1536 x 1152 pixels: 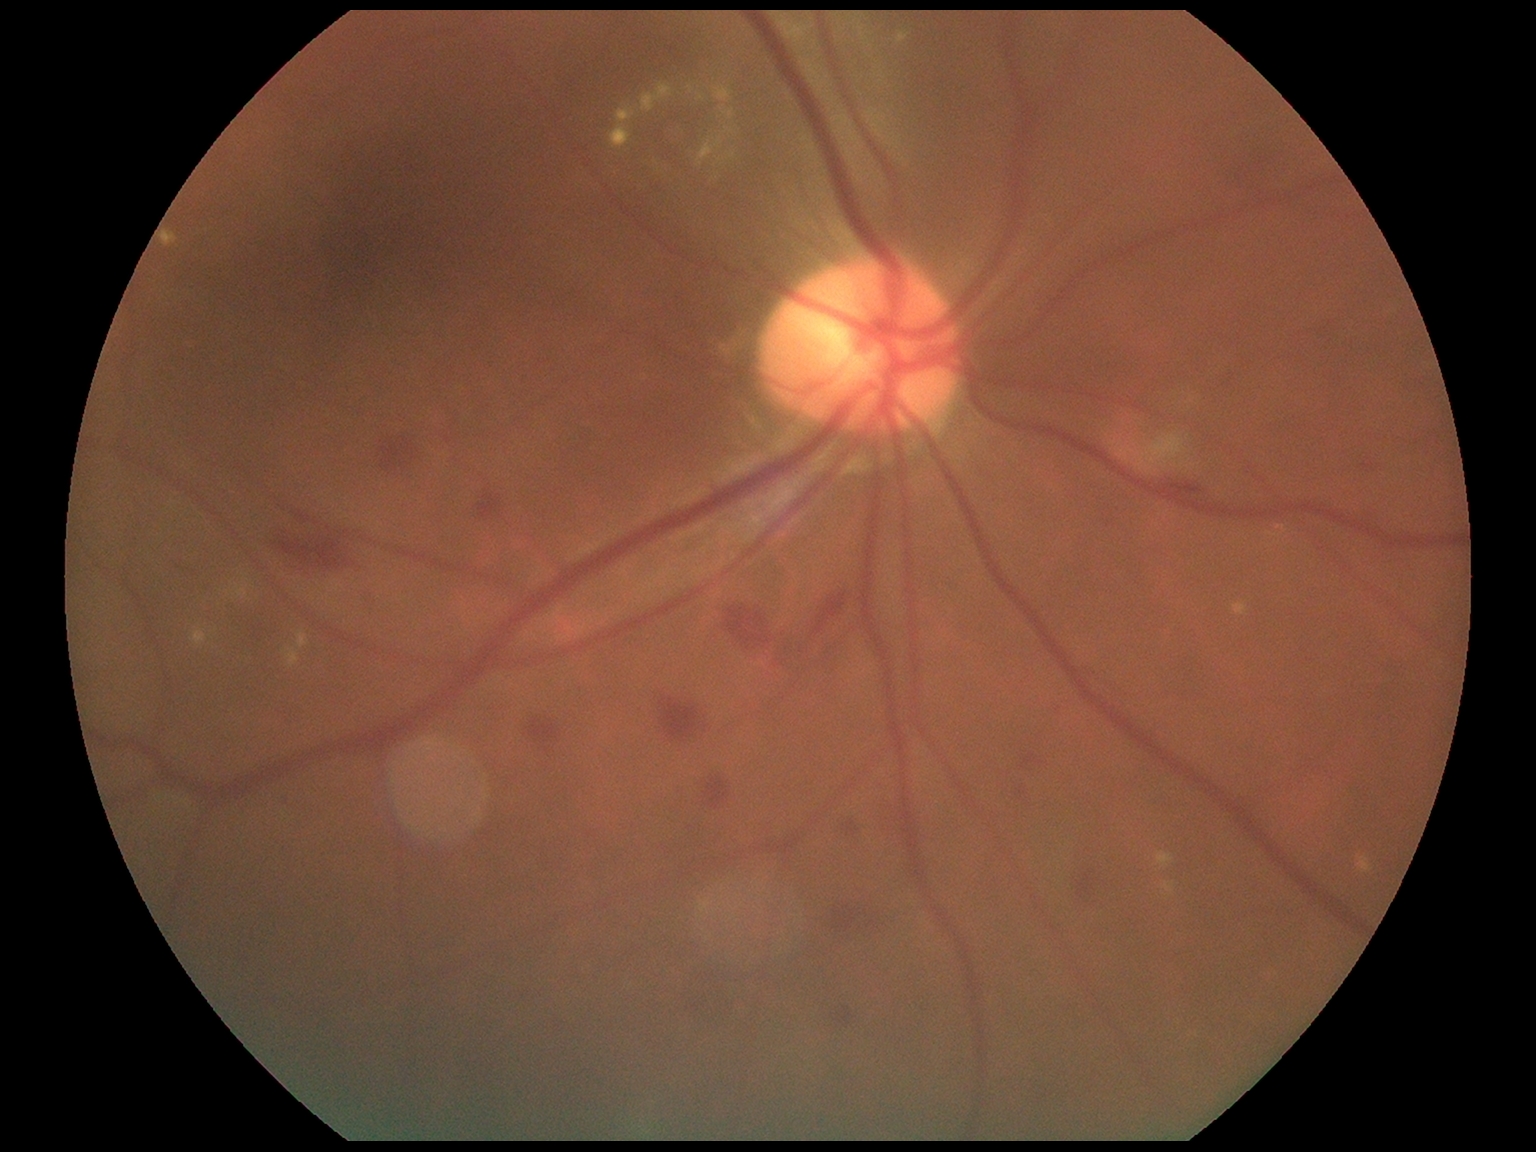 DR severity: grade 2 (moderate NPDR).